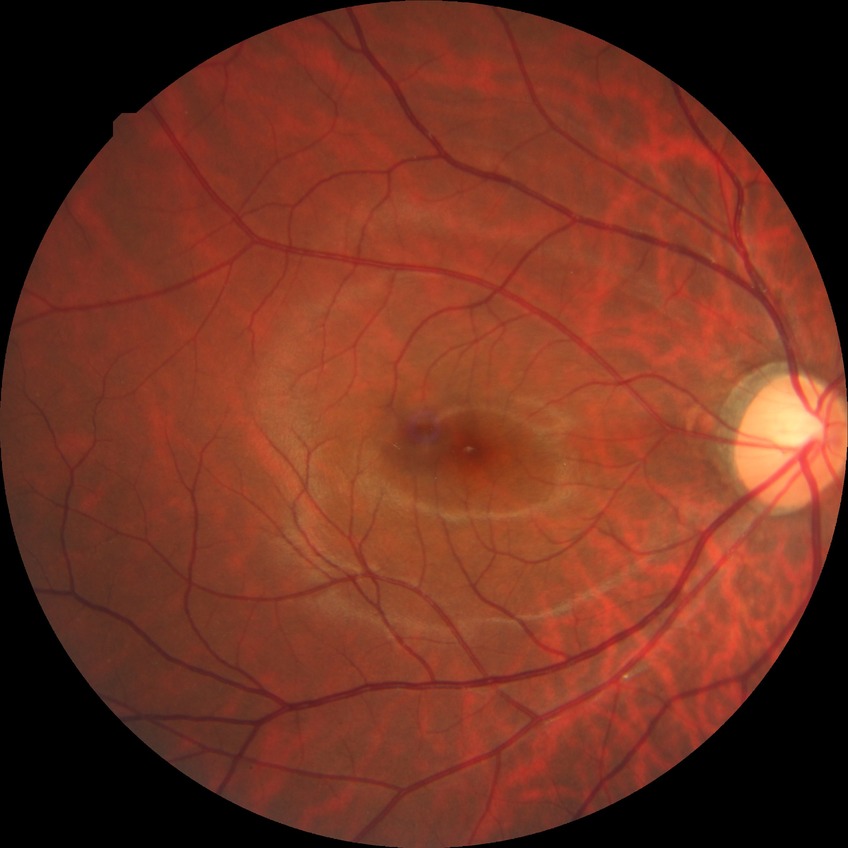
Modified Davis classification: no diabetic retinopathy.